Retinal fundus photograph · field includes the optic disc and macula · captured after pupil dilation: 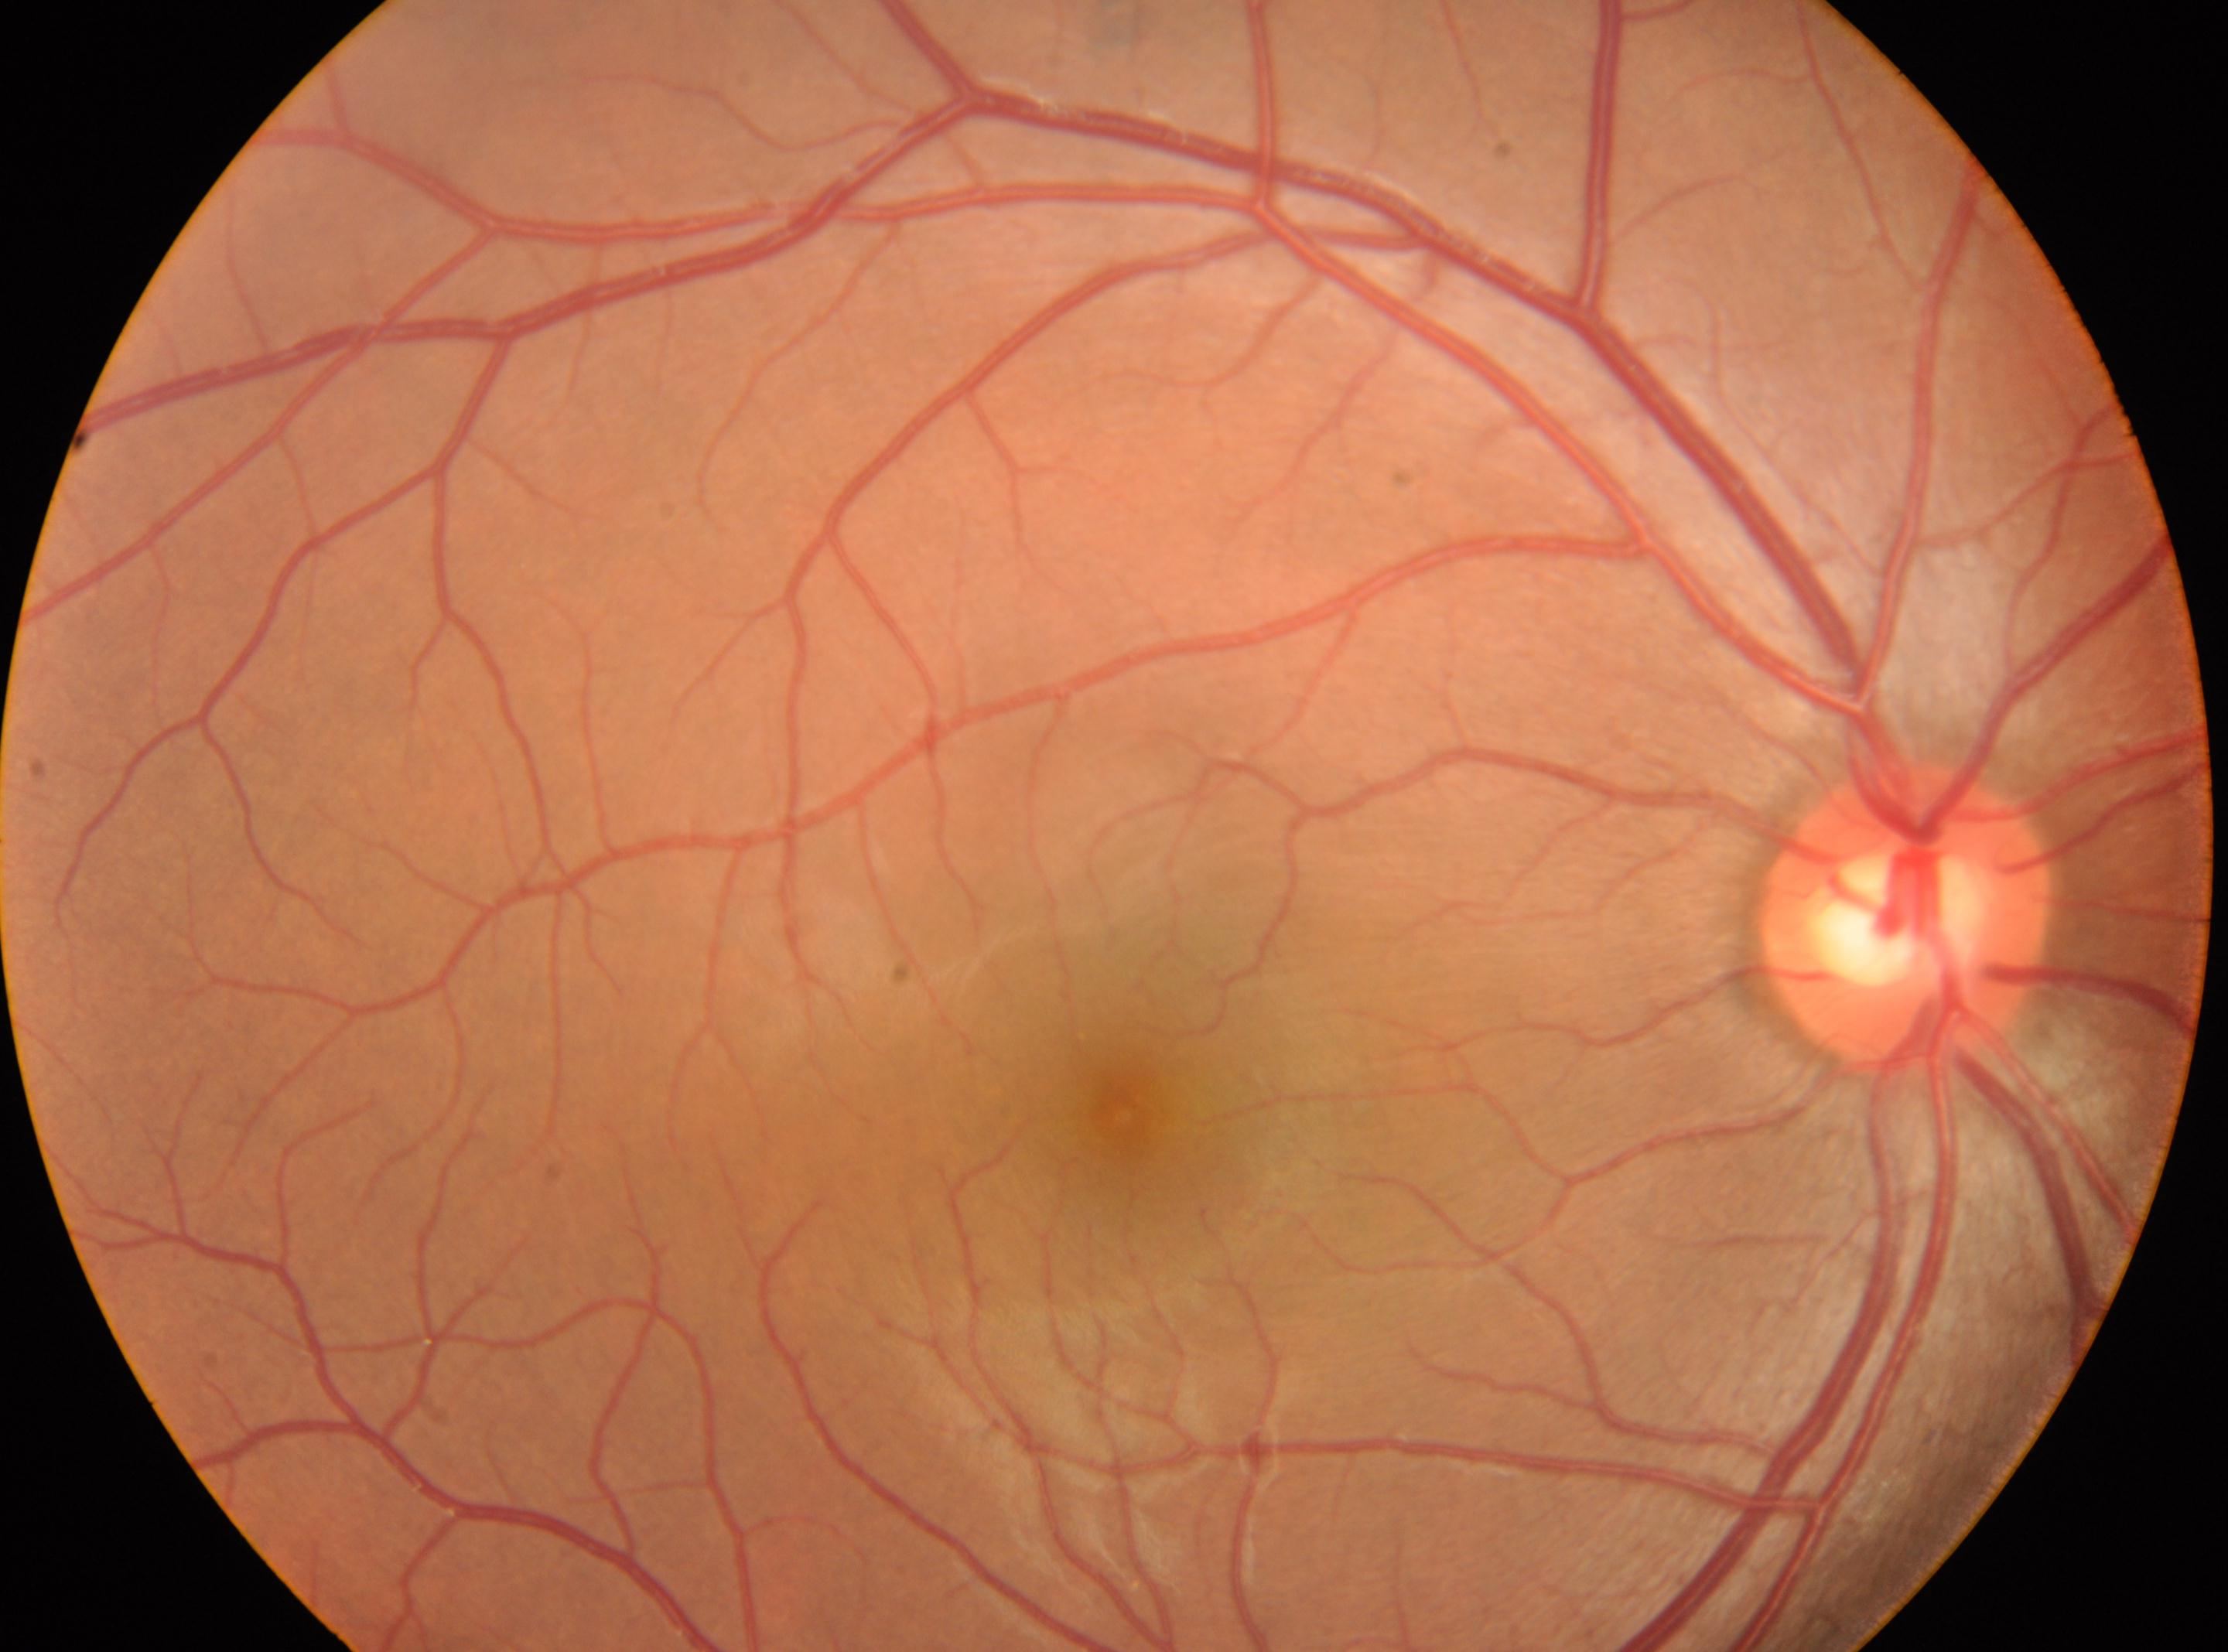
fovea centralis@(x=1120, y=1114) | OD | DR@grade 0 (no apparent retinopathy) | optic disk@(x=1905, y=917).